Infant wide-field retinal image.
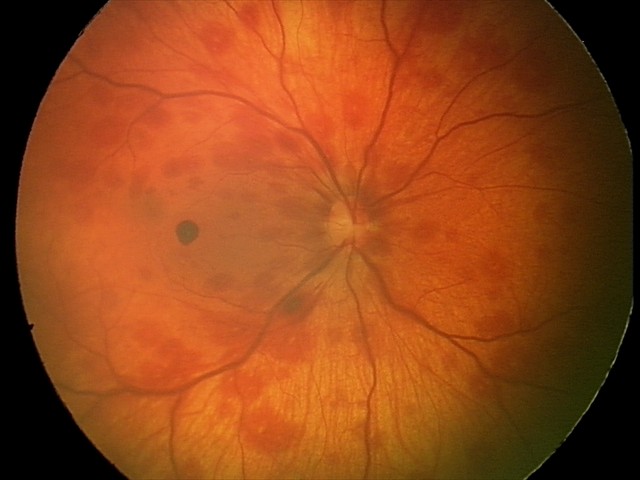

Diagnosis: retinal hemorrhages.